Infant wide-field fundus photograph · captured with the Phoenix ICON (100° field of view): 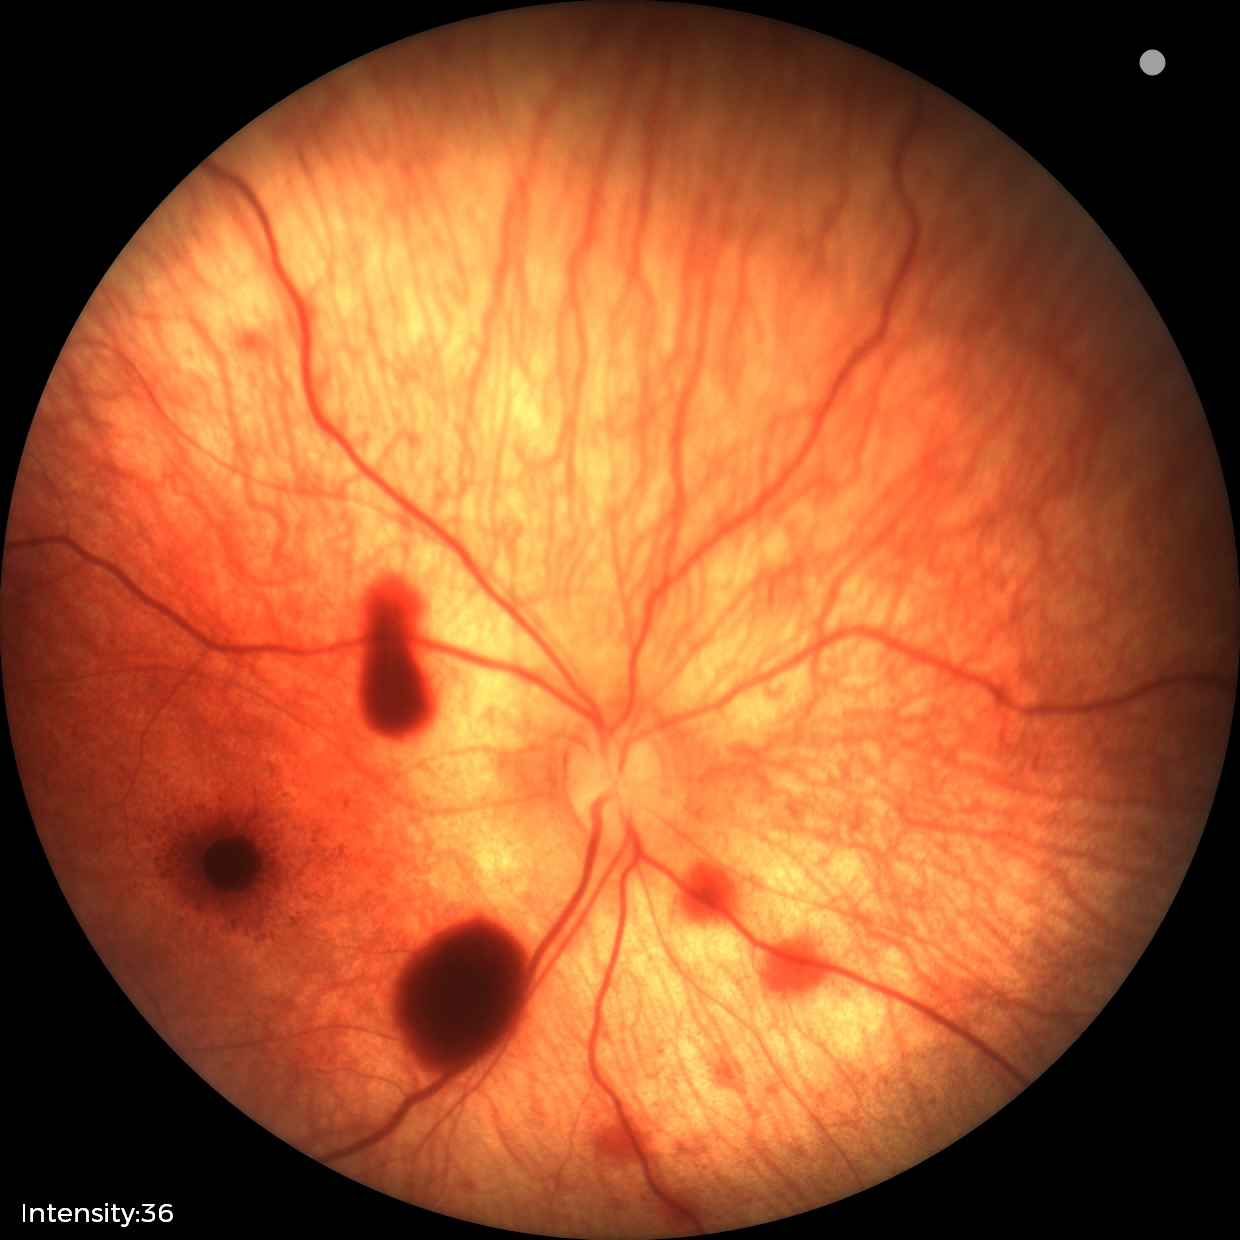
Series diagnosed as retinal hemorrhages.